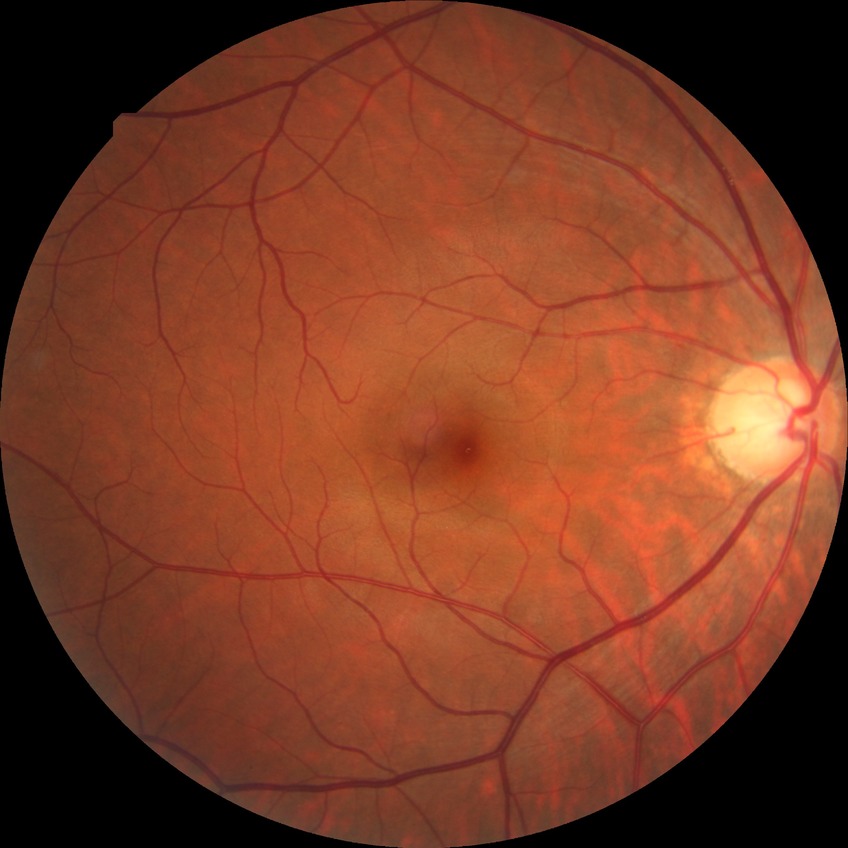

DR impression = no DR findings; Davis DR grade = NDR.